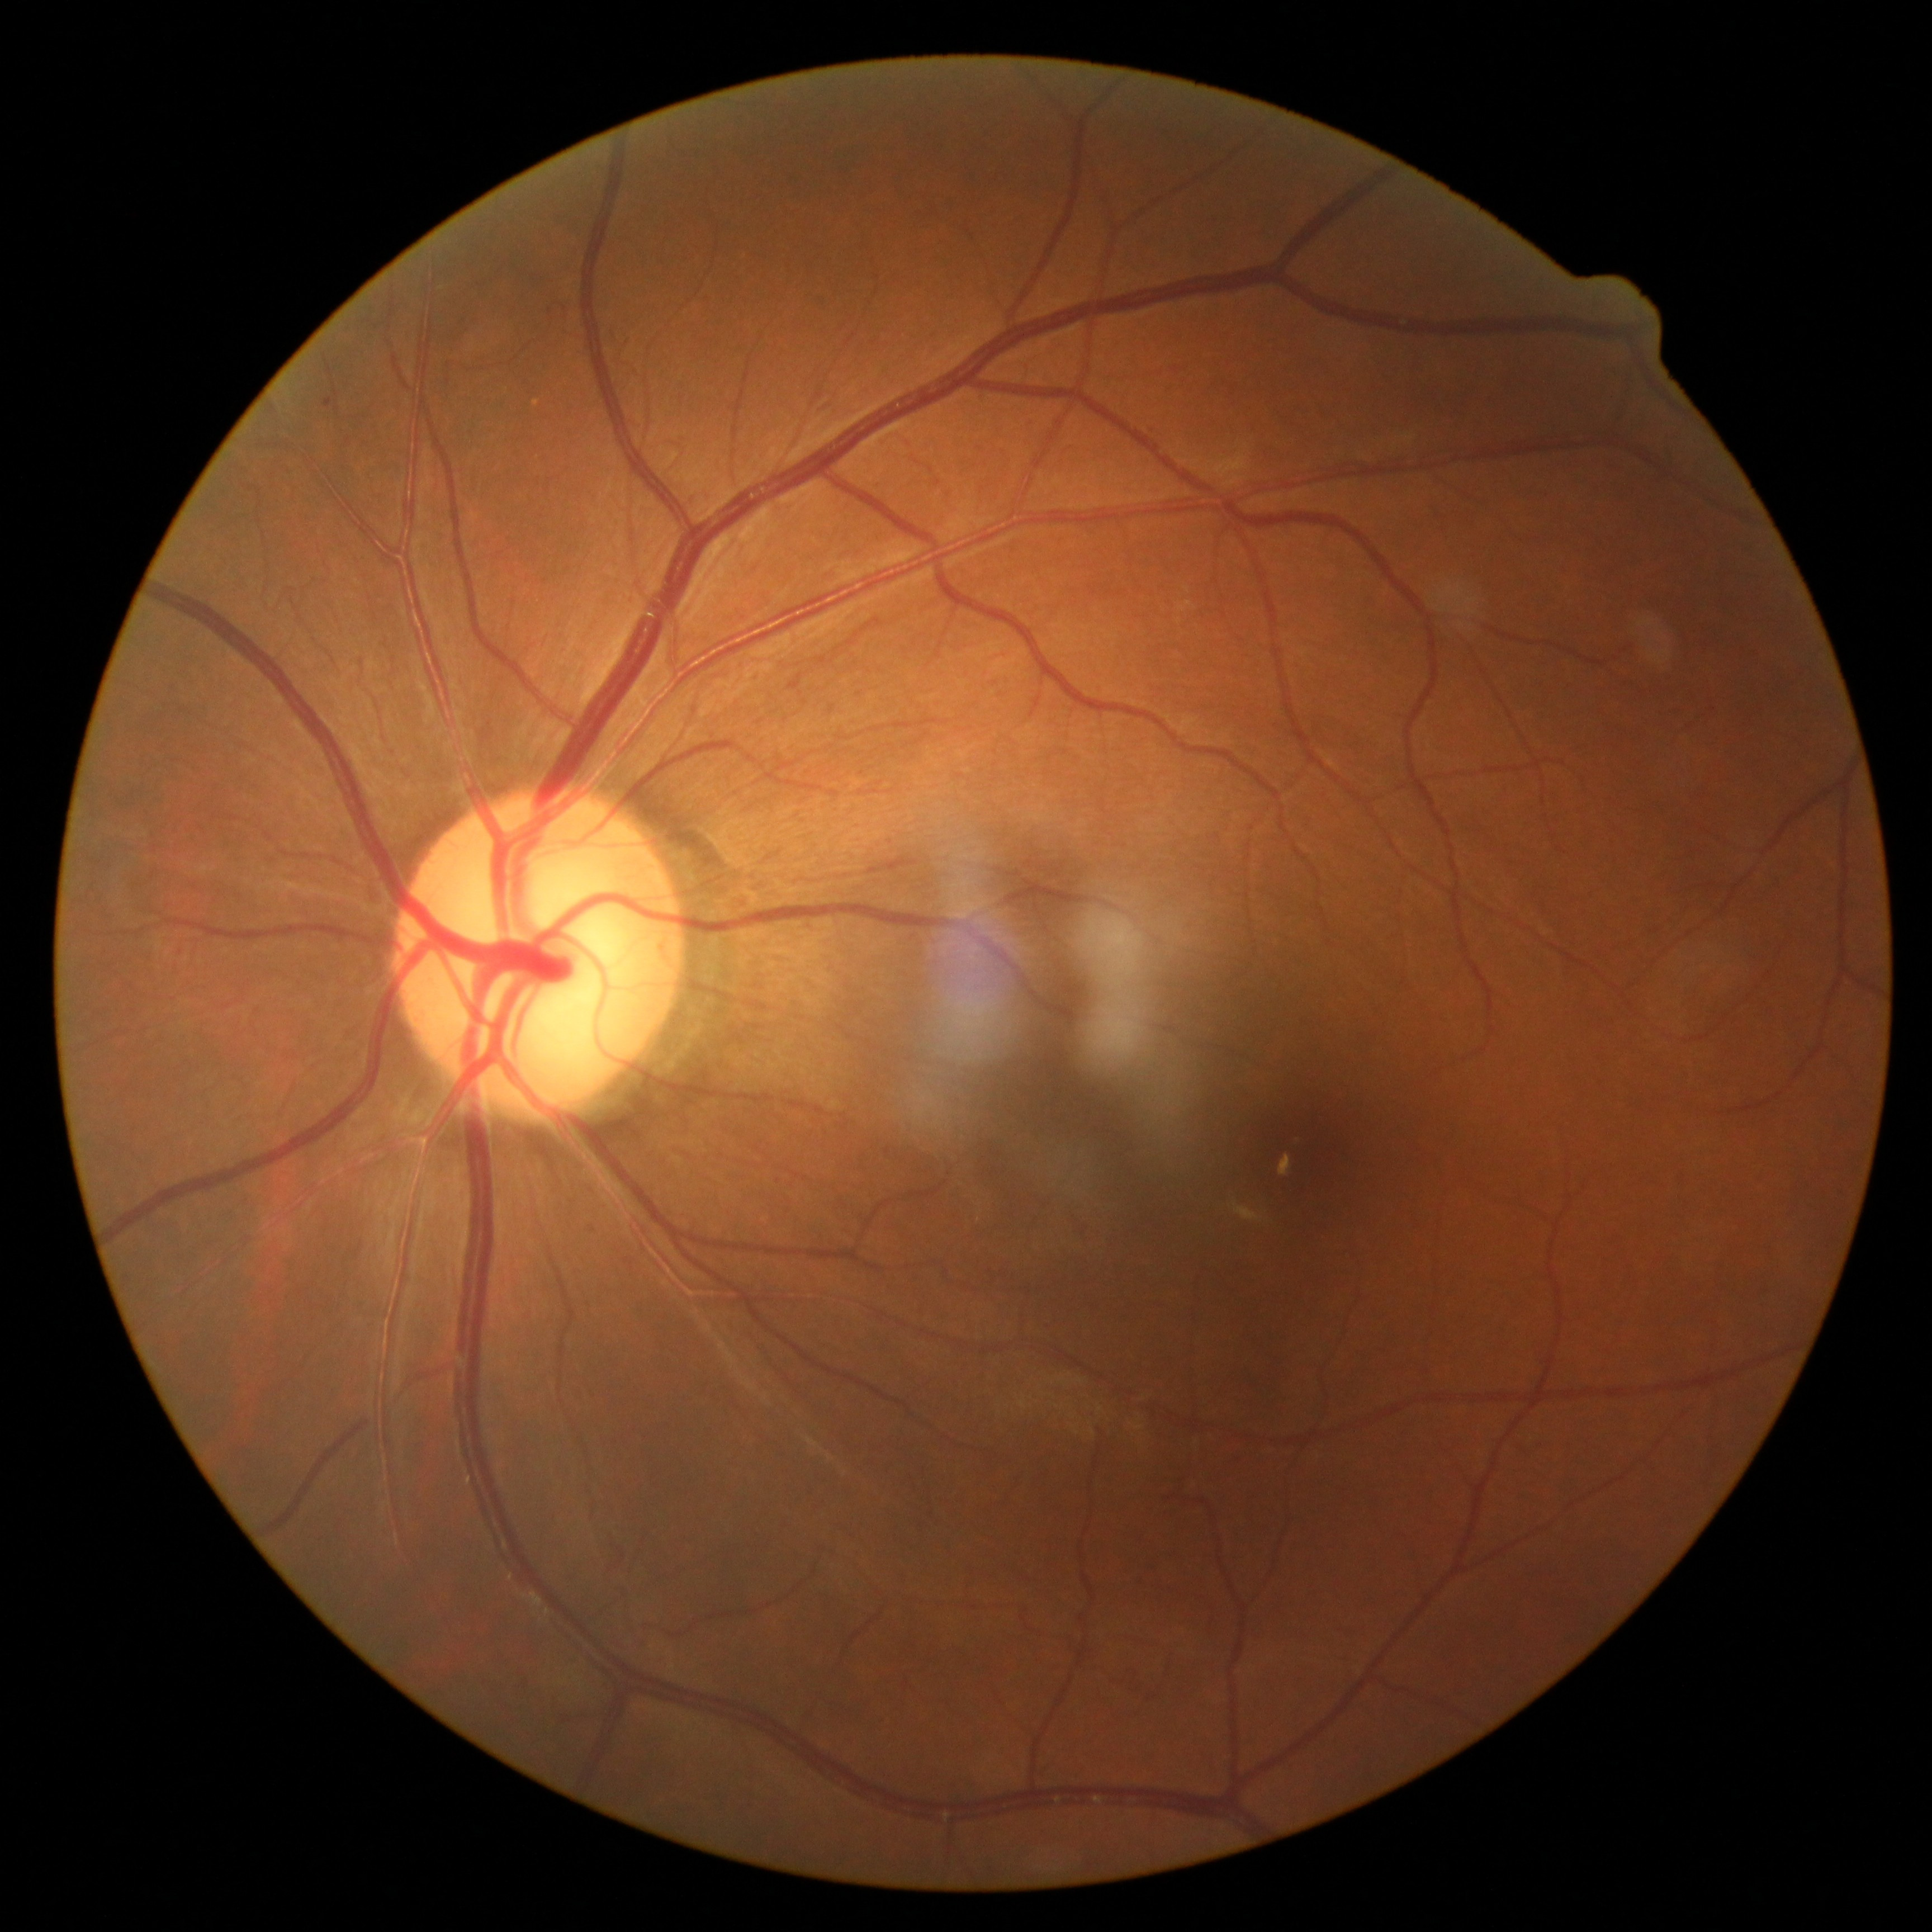
DR stage: 1/4 — presence of microaneurysms only.